45-degree field of view; CFP; 2352 by 1568 pixels:
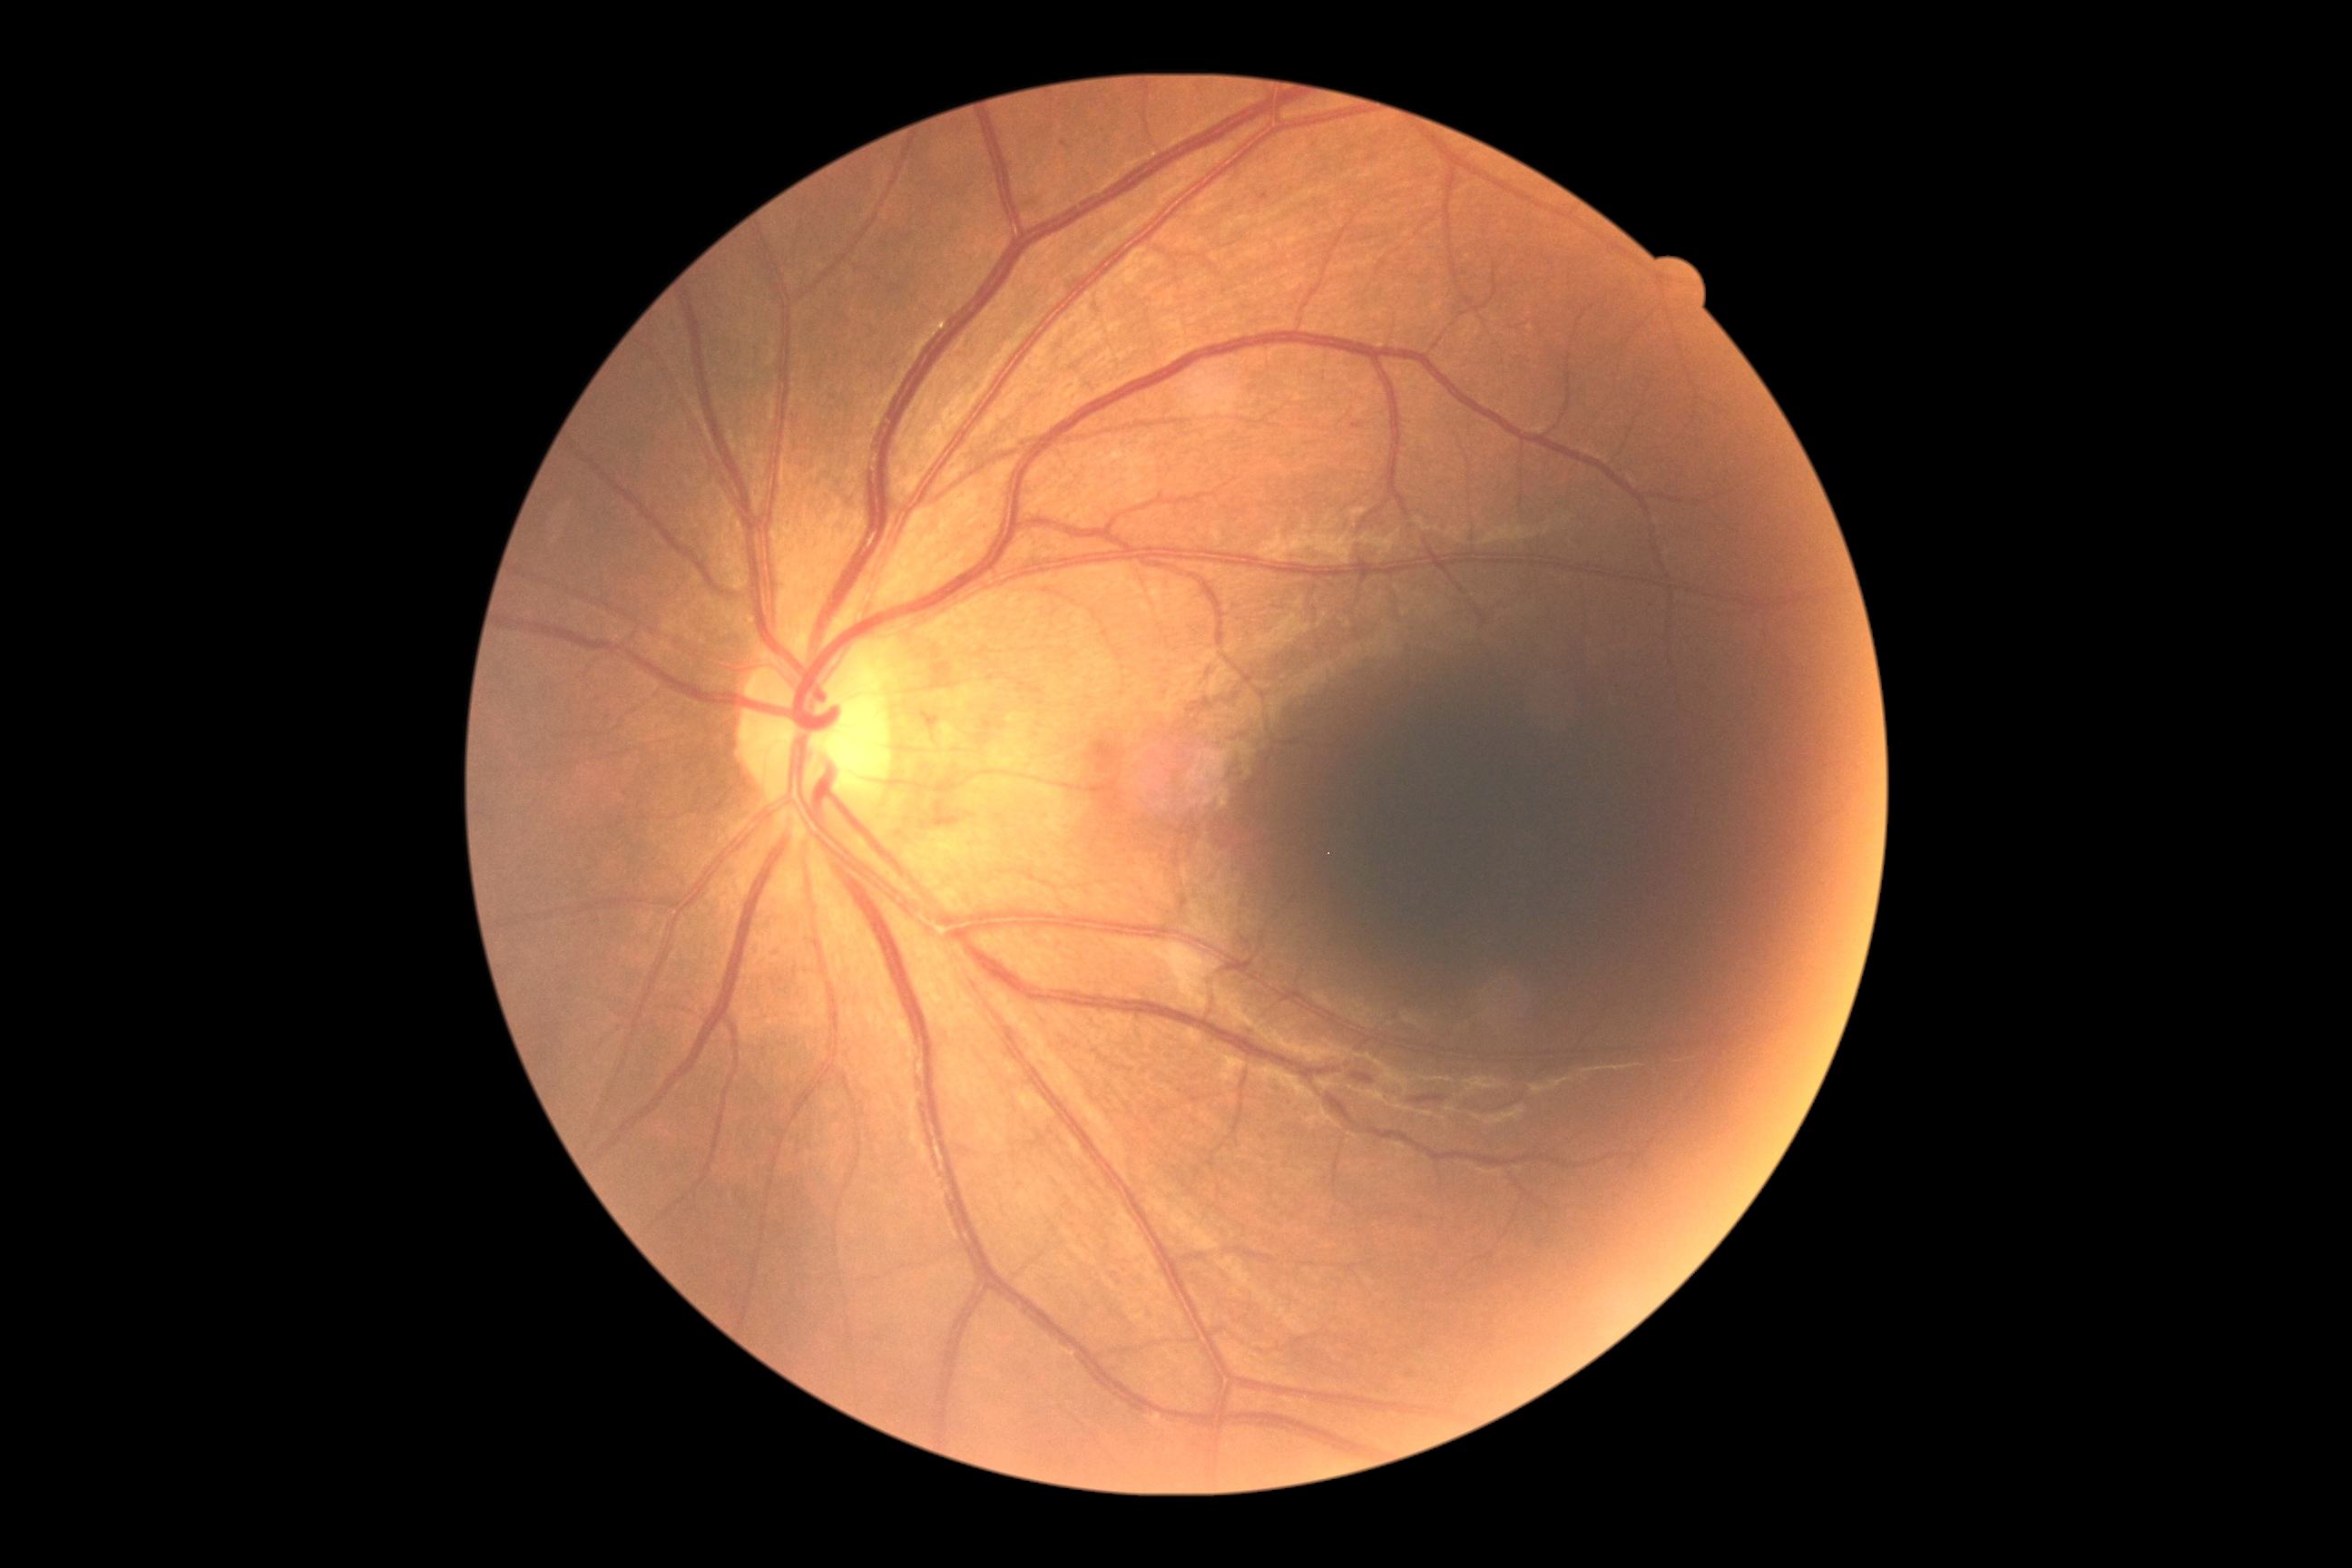 DR severity is mild non-proliferative diabetic retinopathy (grade 1) — presence of microaneurysms only.